848x848:
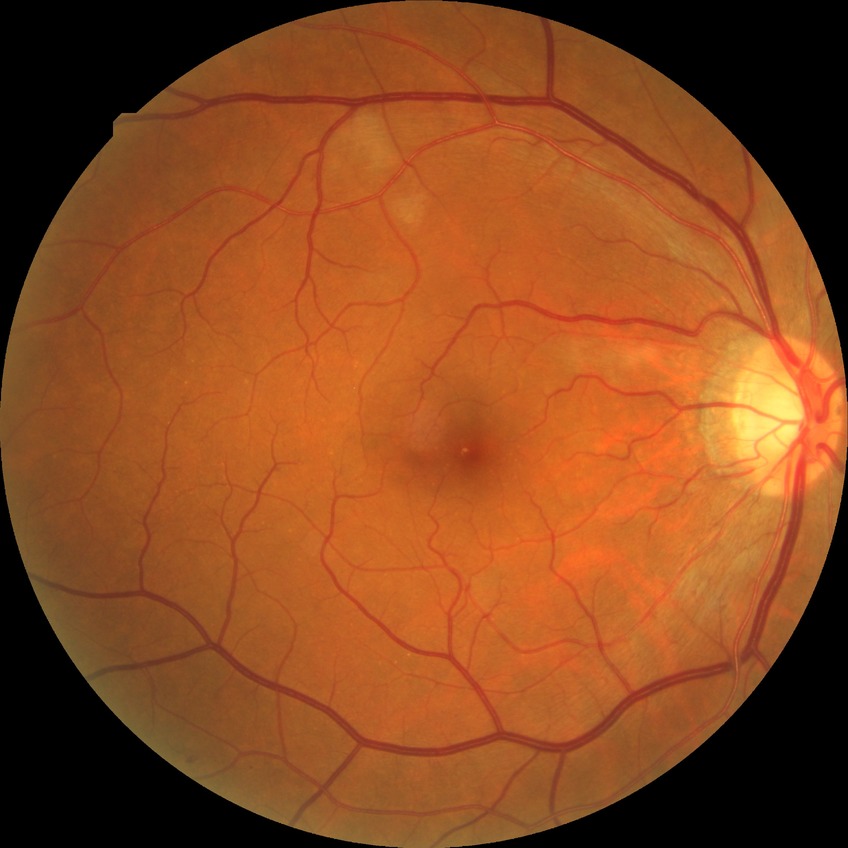 Assessment:
* Davis stage: PPDR